1920 x 1440 pixels; fundus photo; camera: Bosch fundus camera — 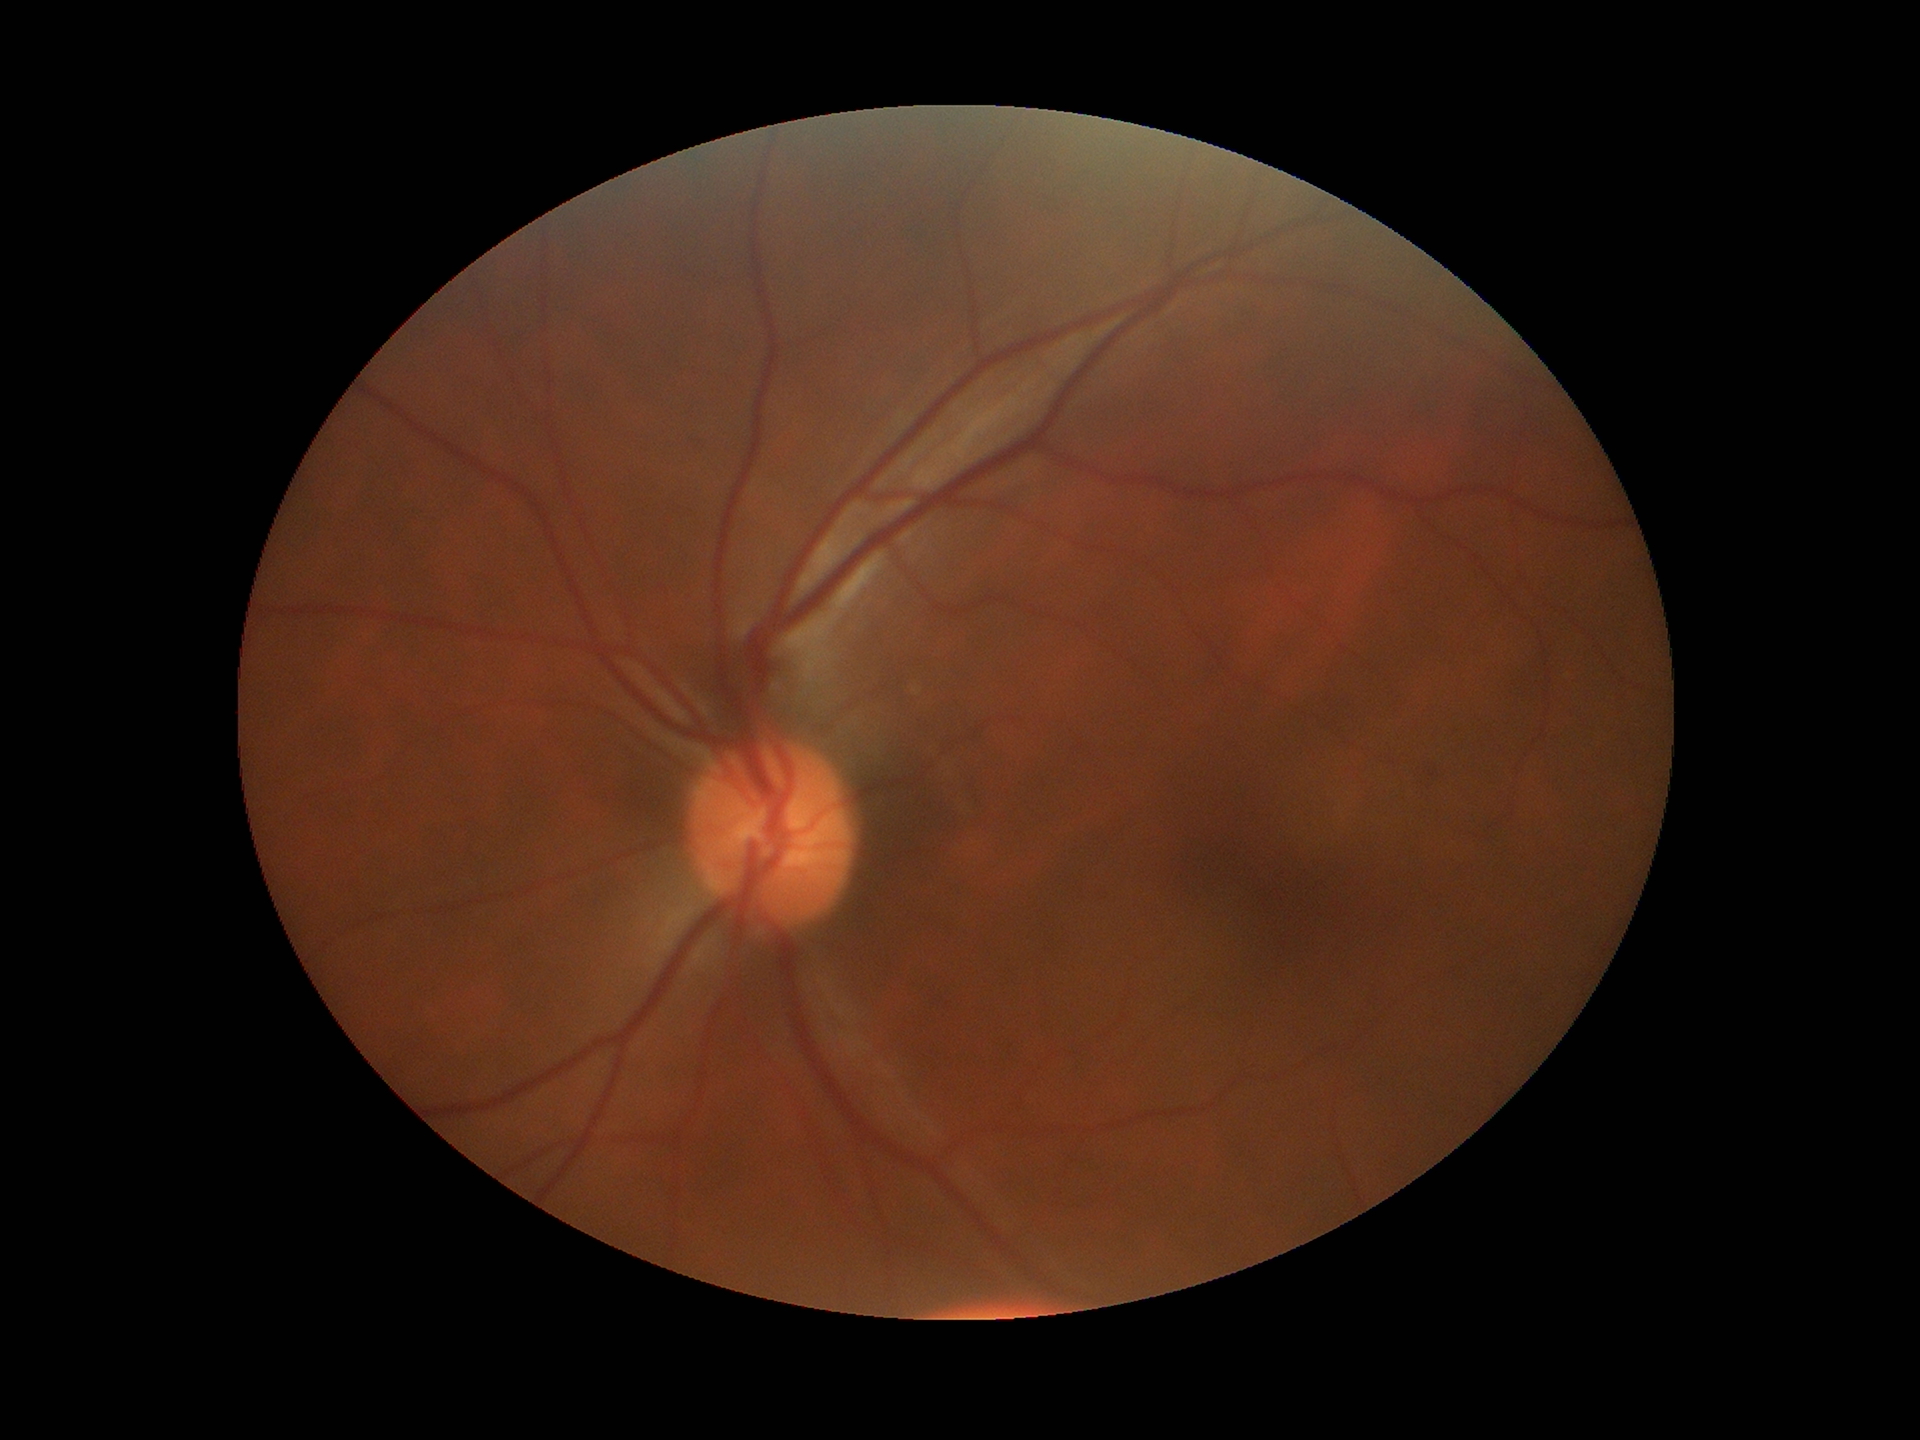
Q: Vertical CDR?
A: 0.46
Q: What is the glaucoma assessment?
A: no suspicious findings
Q: What is the area cup-to-disc ratio?
A: 0.22